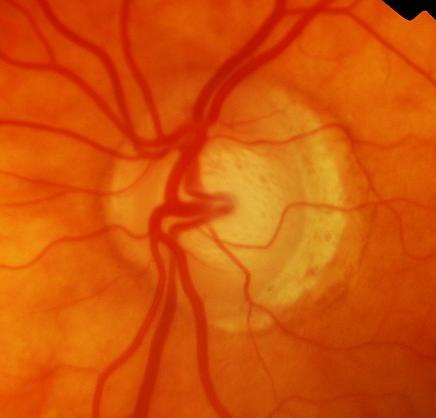

Glaucoma diagnosis: evidence of glaucoma.